Color fundus image. 2212 by 1659 pixels. 45-degree field of view:
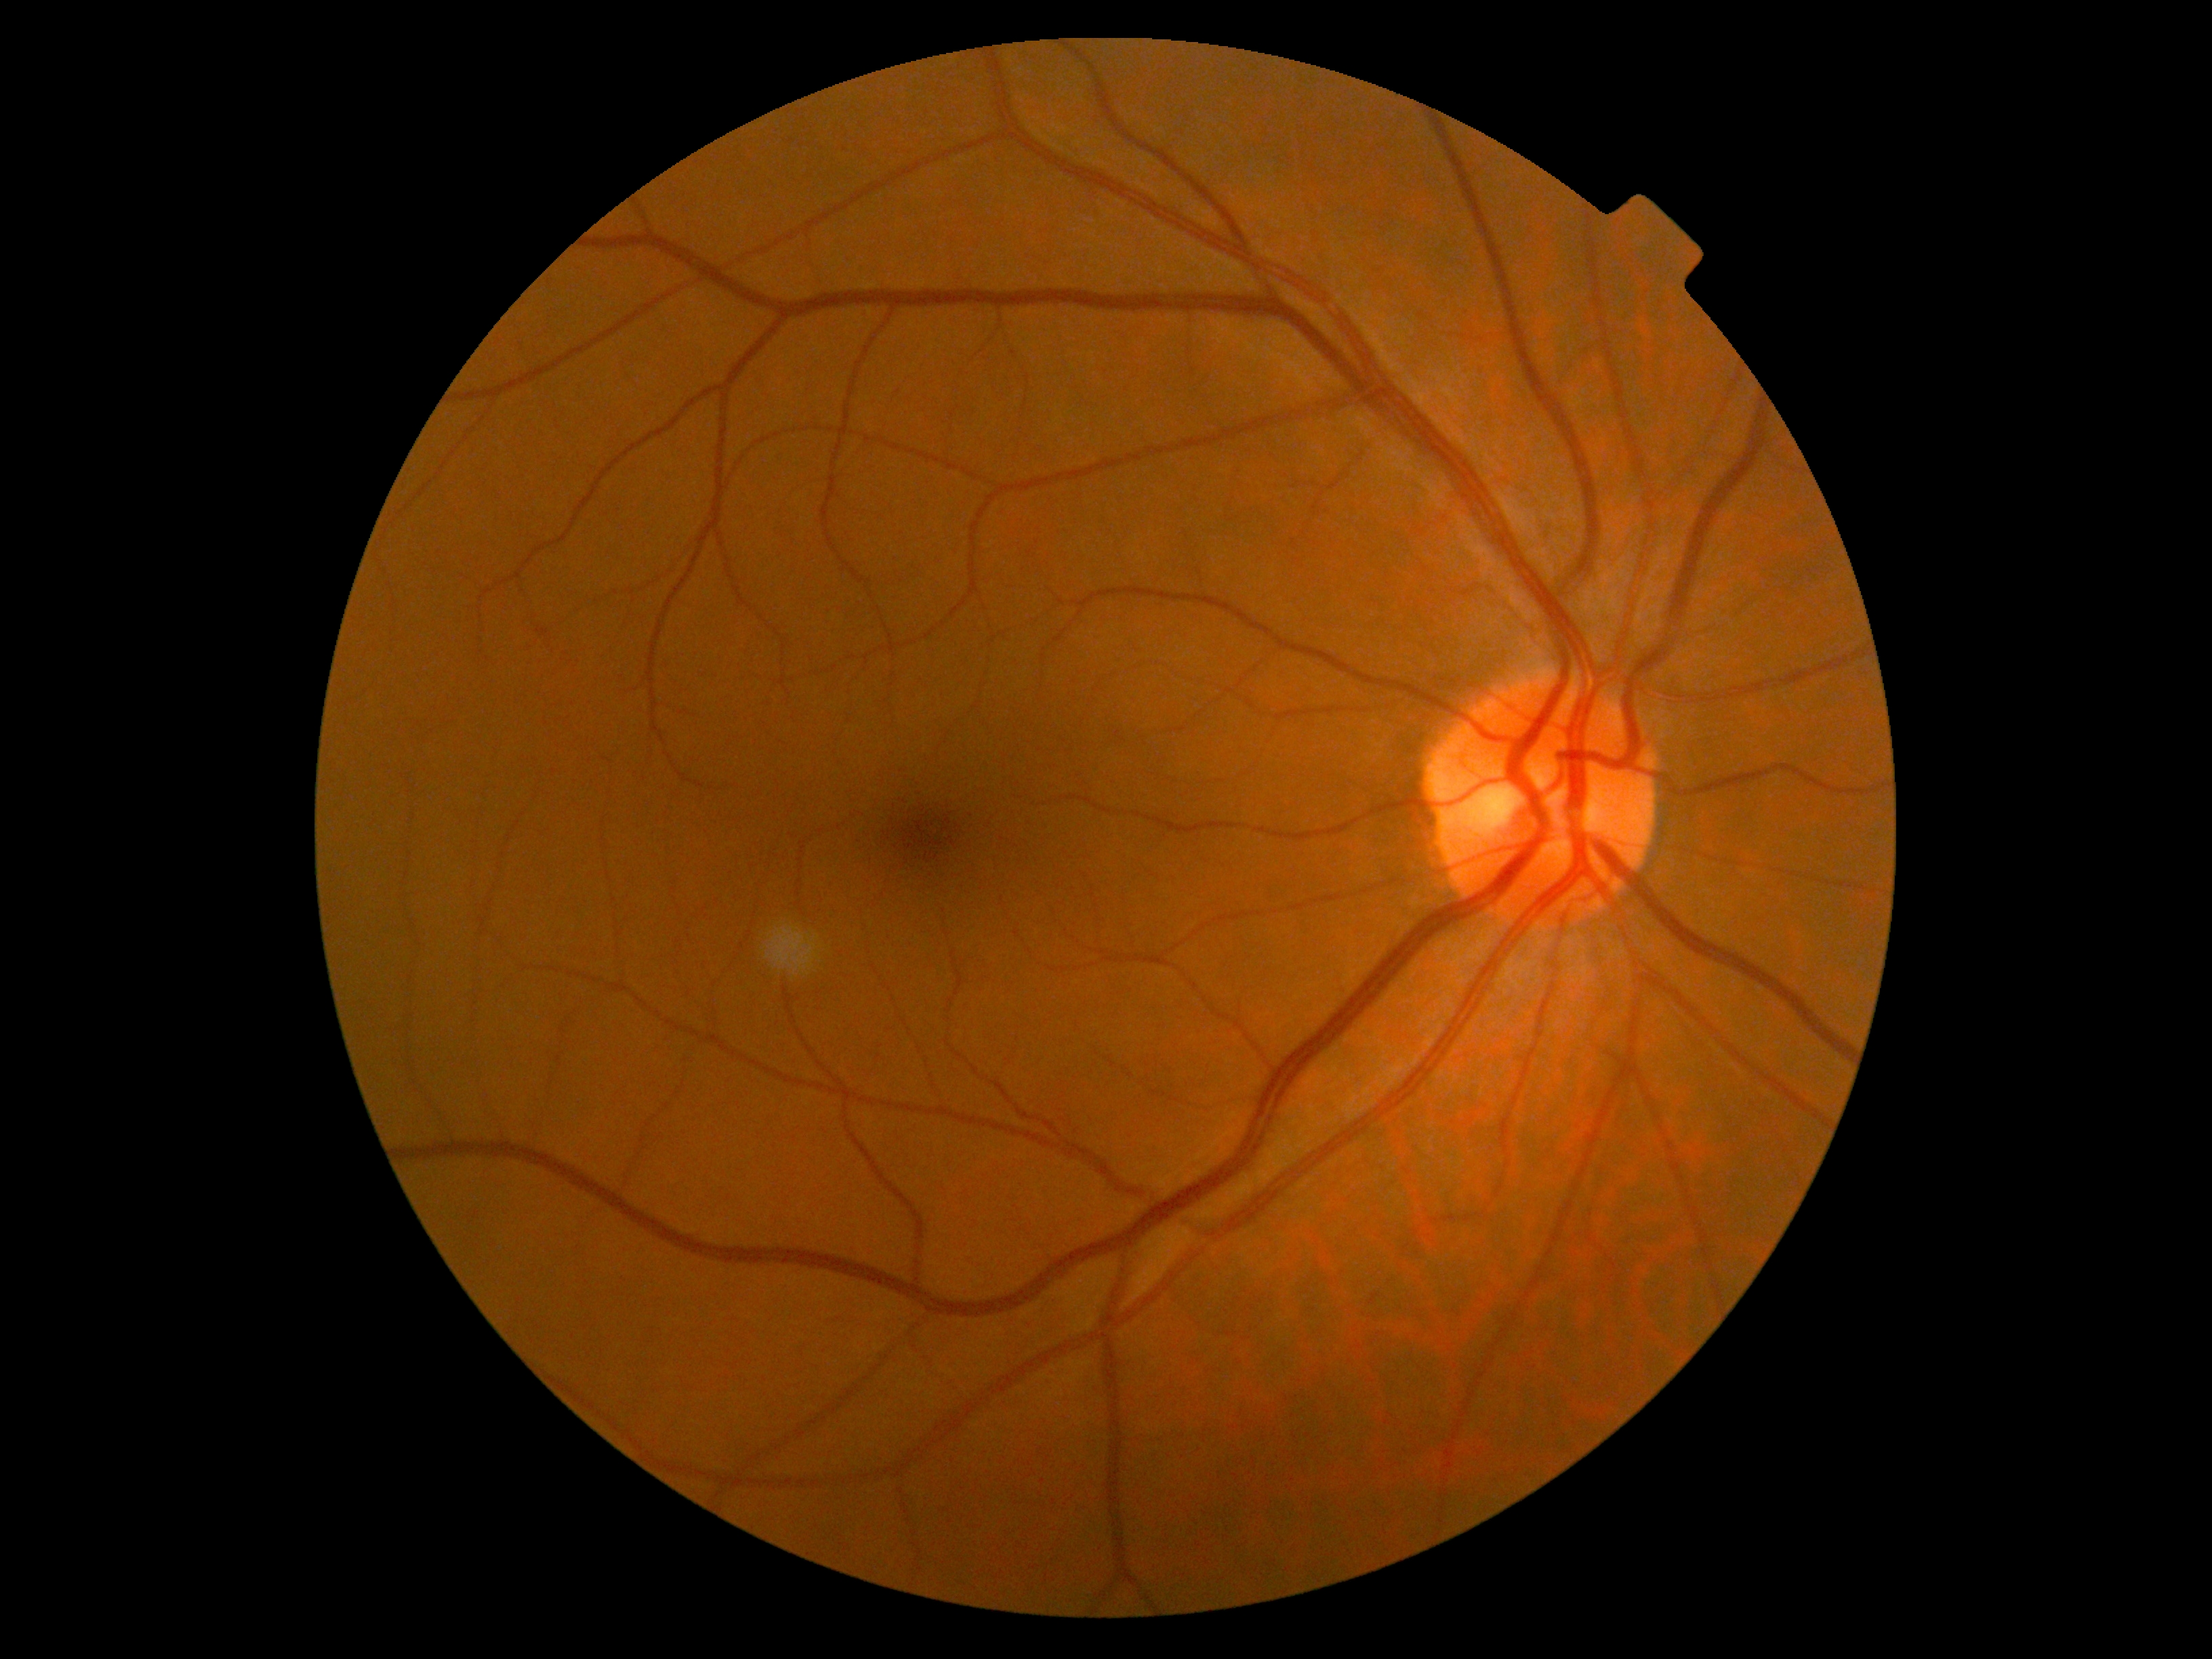 Diabetic retinopathy grade: 0.